Without pupil dilation; modified Davis classification; 45 degree fundus photograph; acquired with a NIDEK AFC-230:
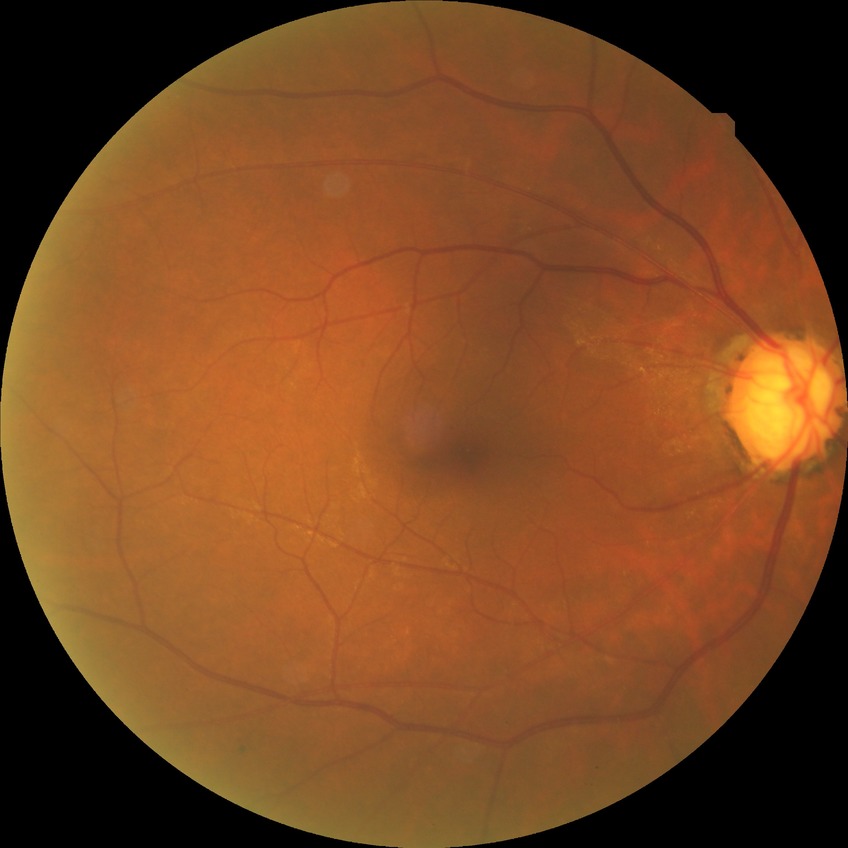

Diabetic retinopathy (DR): no diabetic retinopathy (NDR).